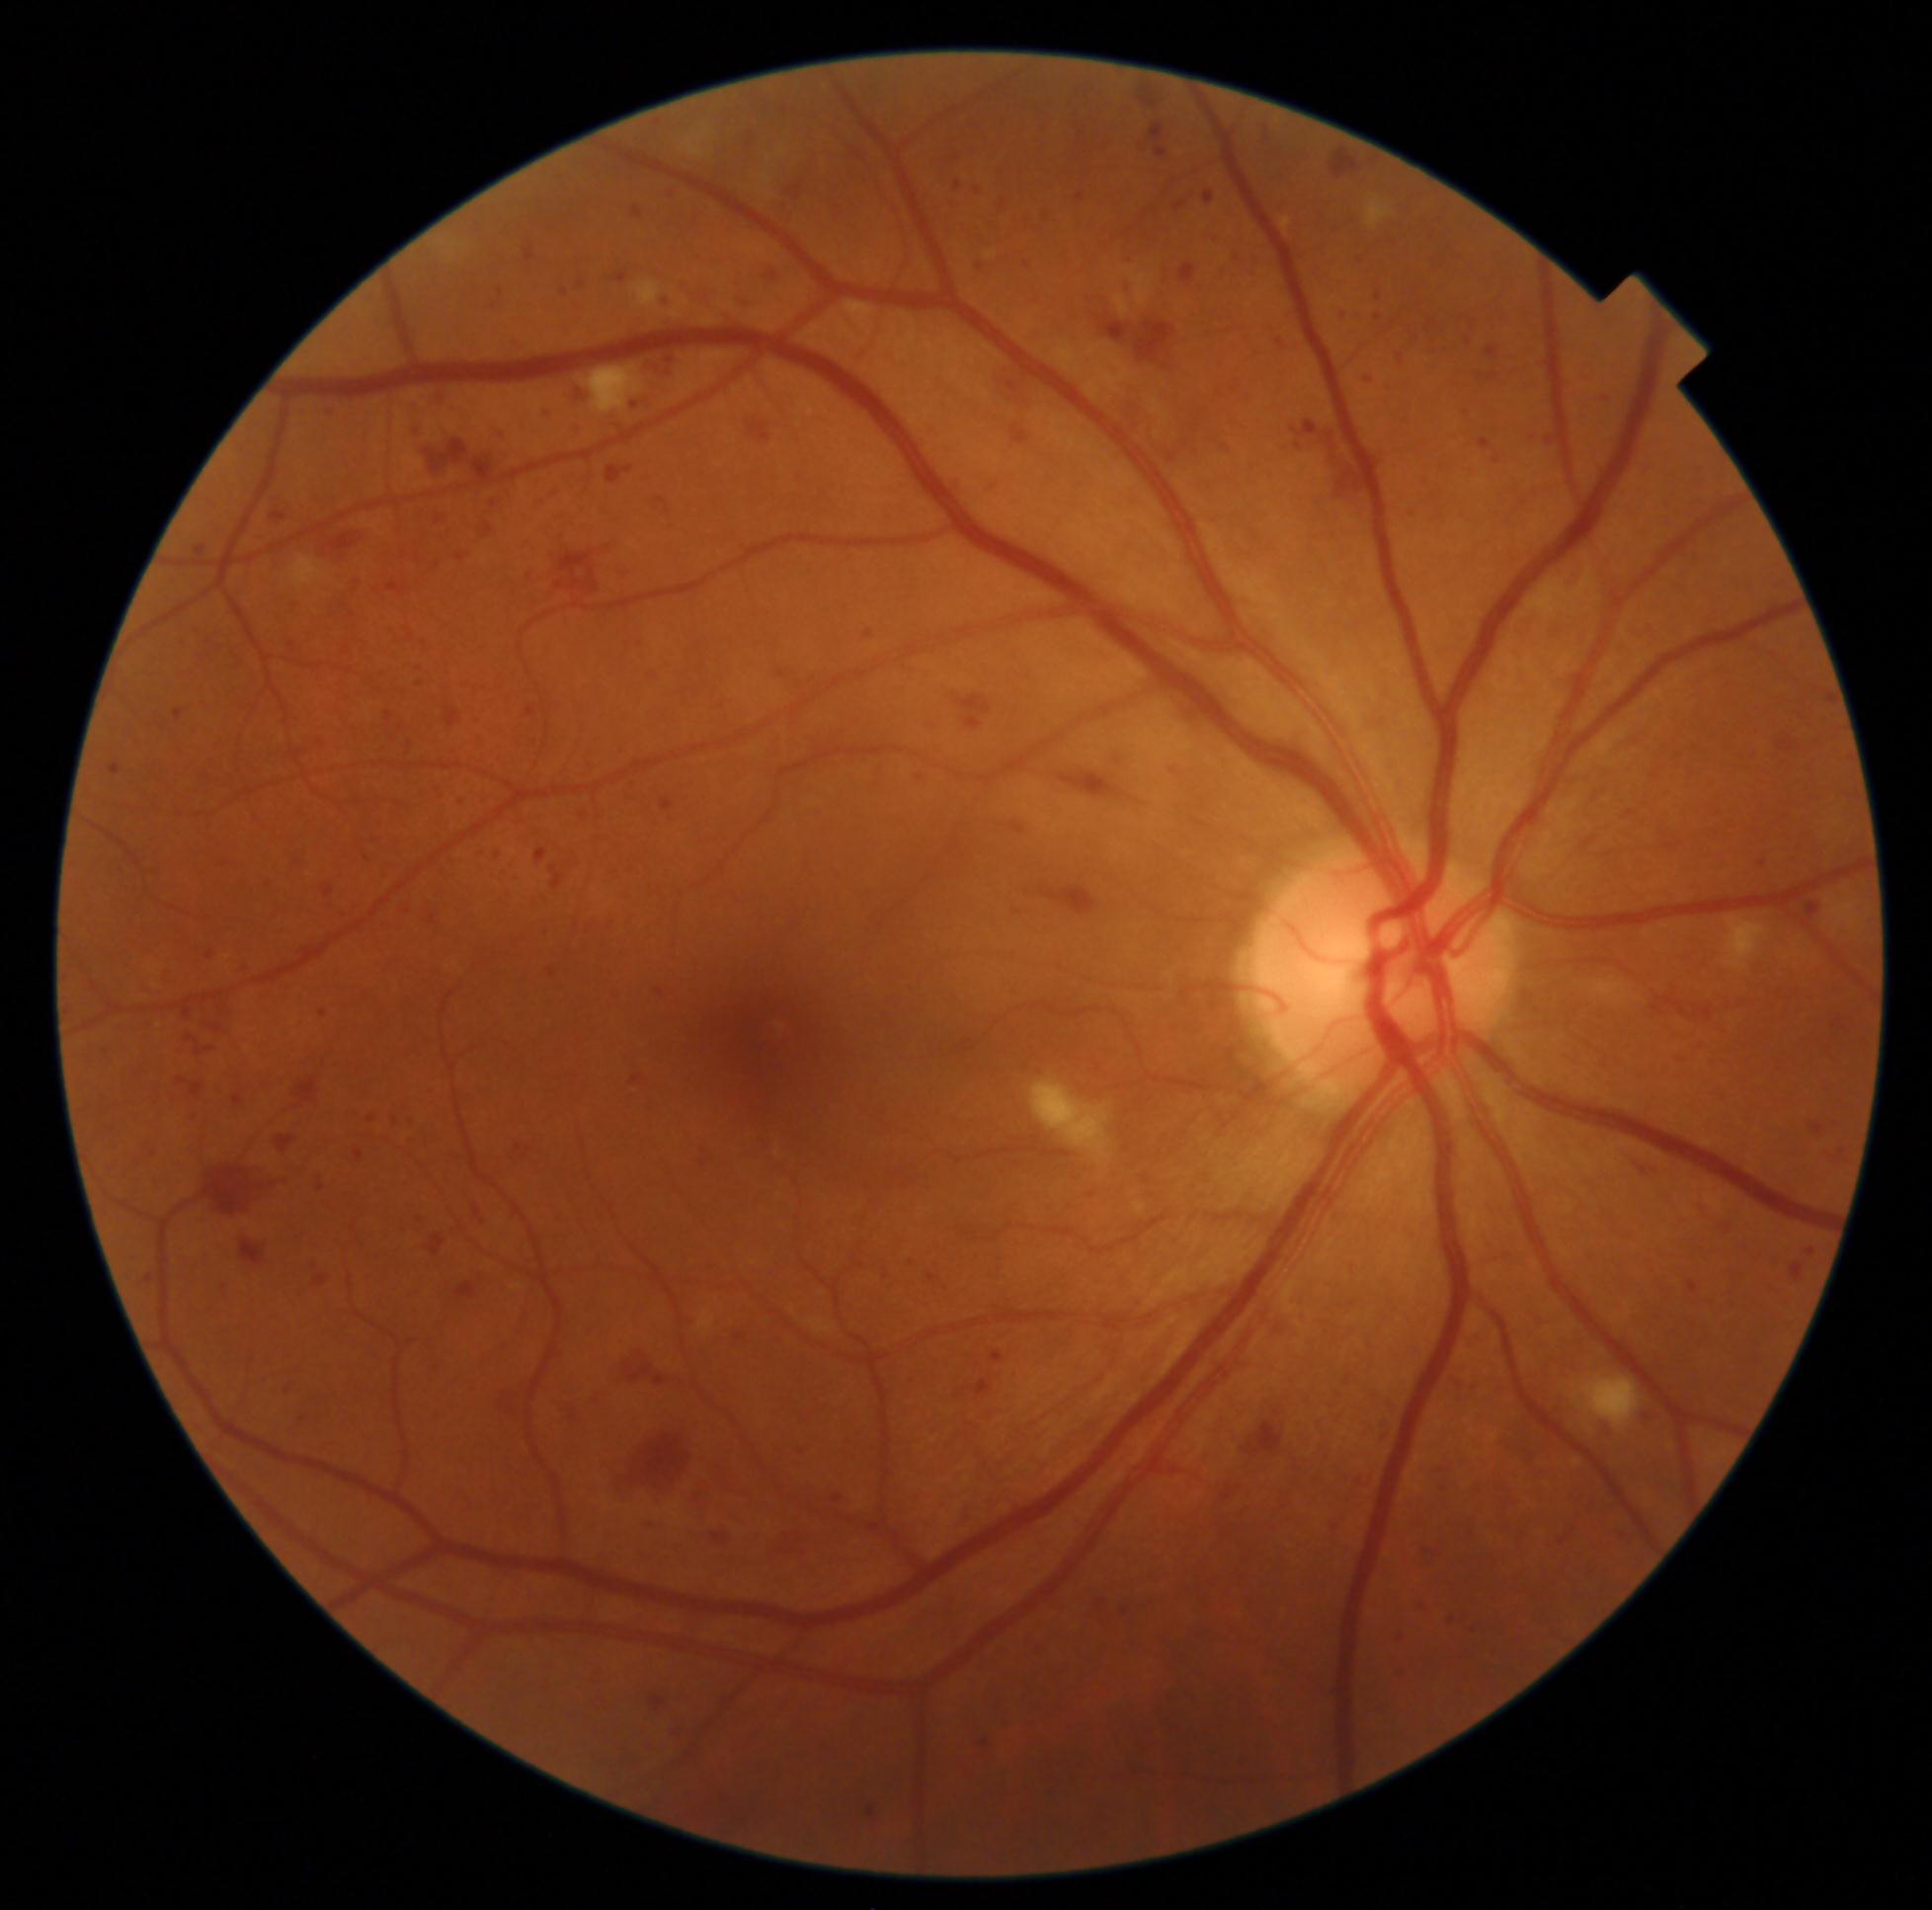 Diabetic retinopathy grade is 3 (severe NPDR)
A subset of detected lesions:
hemorrhages (subset): (x1=948, y1=199, x2=964, y2=213) | (x1=307, y1=1255, x2=332, y2=1288) | (x1=616, y1=1348, x2=696, y2=1398) | (x1=70, y1=858, x2=79, y2=874) | (x1=982, y1=1741, x2=990, y2=1748) | (x1=312, y1=1007, x2=331, y2=1020) | (x1=618, y1=892, x2=634, y2=903) | (x1=477, y1=797, x2=489, y2=808) | (x1=650, y1=1697, x2=666, y2=1709) | (x1=548, y1=969, x2=557, y2=978) | (x1=177, y1=1007, x2=195, y2=1024) | (x1=259, y1=876, x2=279, y2=897) | (x1=1404, y1=323, x2=1421, y2=344) | (x1=1525, y1=1449, x2=1541, y2=1470) | (x1=1041, y1=210, x2=1059, y2=226) | (x1=172, y1=1072, x2=209, y2=1104) | (x1=625, y1=392, x2=654, y2=412) | (x1=570, y1=383, x2=590, y2=408)
Additional small hemorrhages near x=1238, y=259 | x=1146, y=1179